Phoenix ICON wide-field infant fundus image. Acquired on the Phoenix ICON
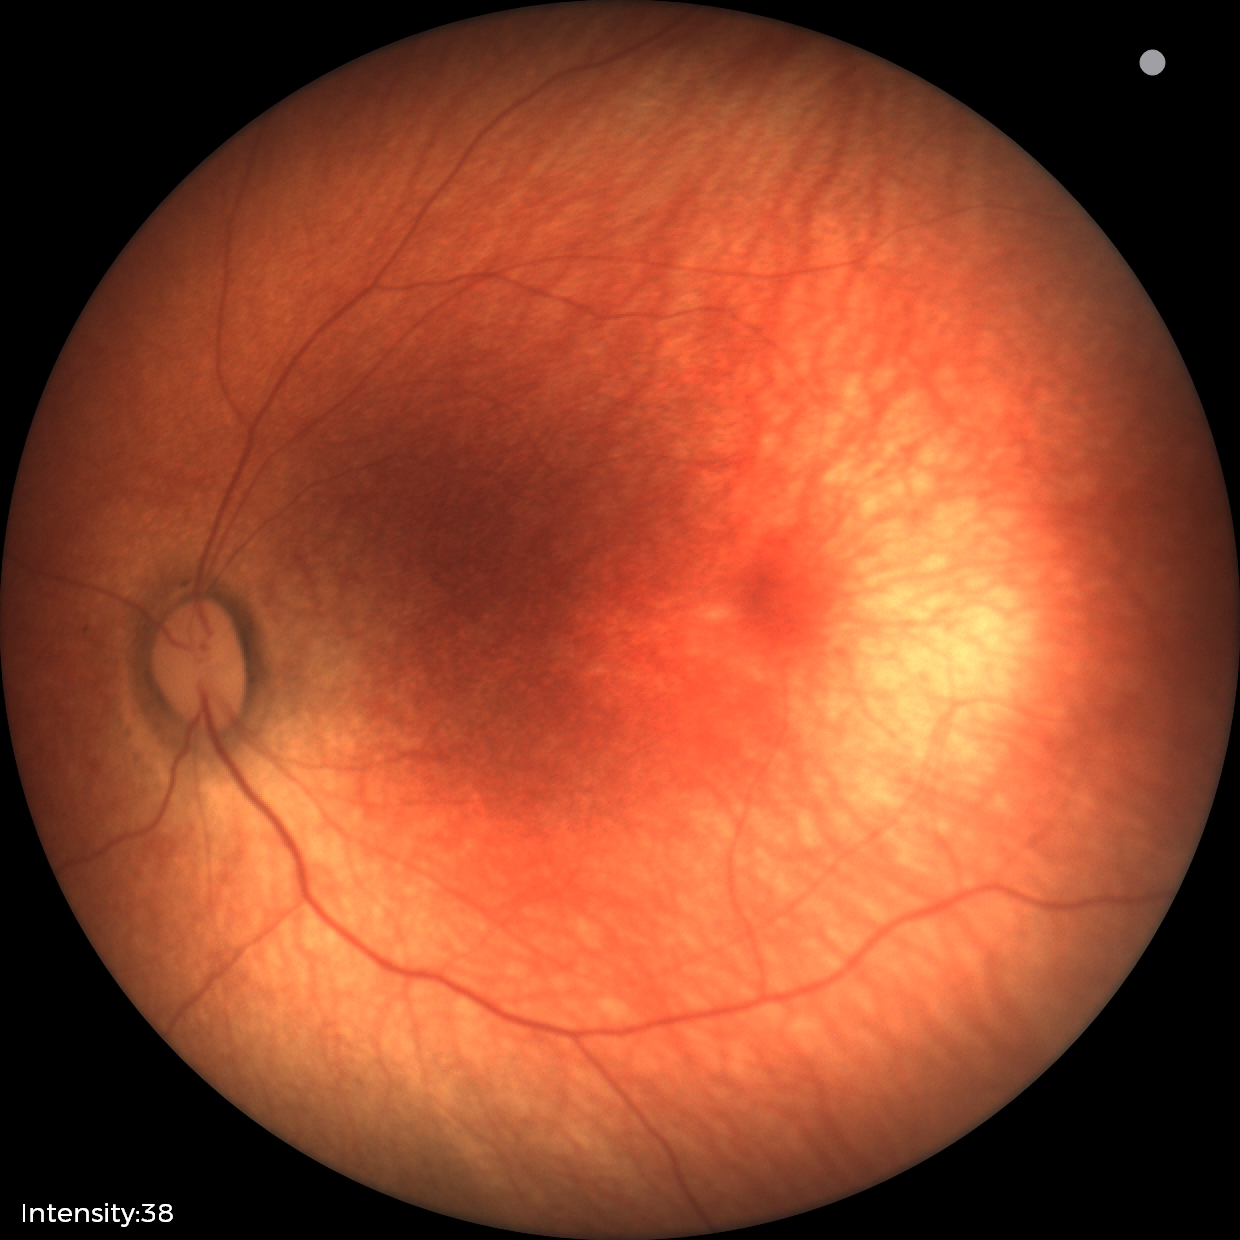

Screening examination with no abnormal retinal findings.